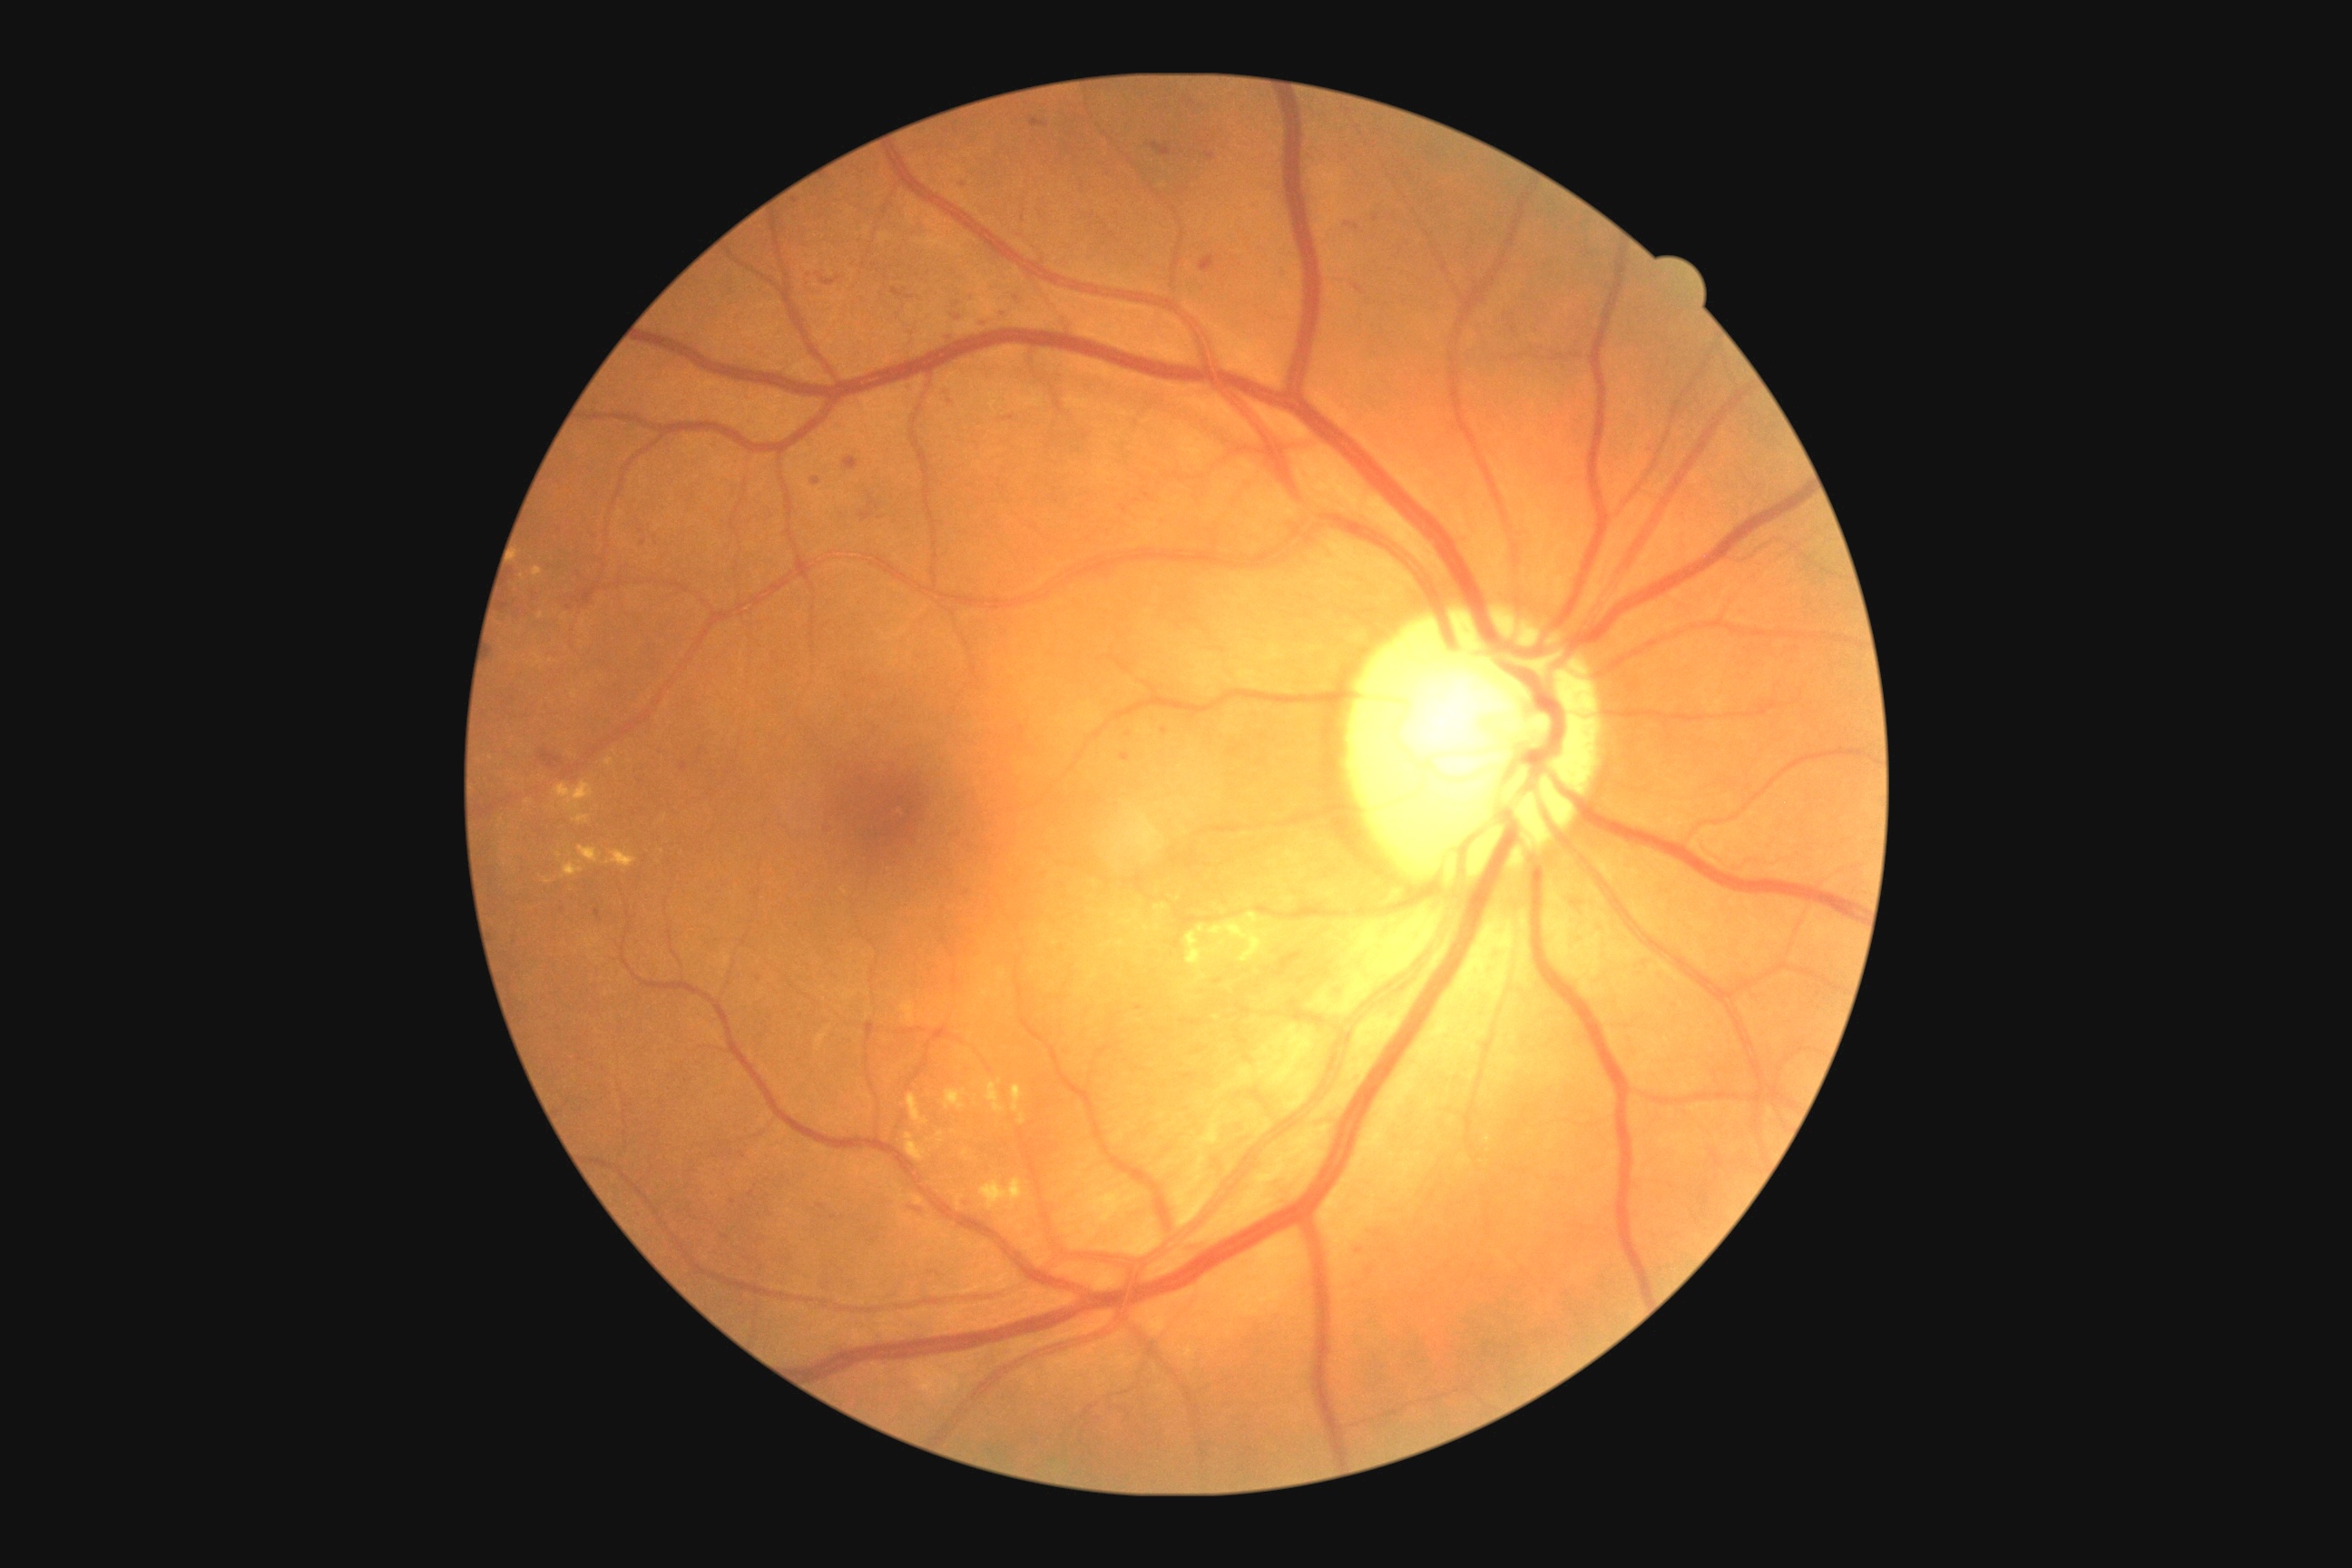
partial: true
dr_grade: 2
dr_grade_name: moderate NPDR
lesions:
  he:
    - 574, 587, 598, 609
    - 905, 382, 916, 393
    - 1121, 754, 1130, 763
    - 1275, 952, 1302, 977
    - 1003, 416, 1014, 422
    - 1150, 142, 1171, 157
    - 843, 456, 859, 471
    - 502, 603, 509, 612
    - 943, 331, 957, 344
  he_small_centers:
    - x=752 y=1194
    - x=1130 y=735
    - x=1165 y=732
    - x=1218 y=983
    - x=562 y=910
    - x=963 y=186
    - x=1376 y=218